Image size 848x848. Retinal fundus photograph:
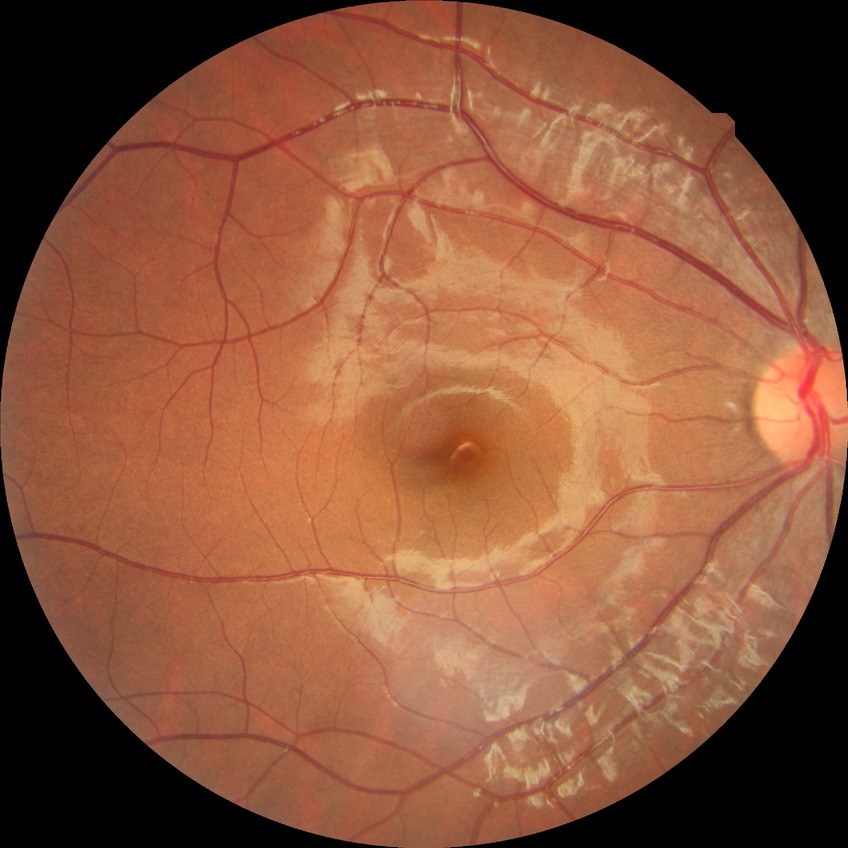 Assessment:
– diabetic retinopathy (DR) — NDR (no diabetic retinopathy)